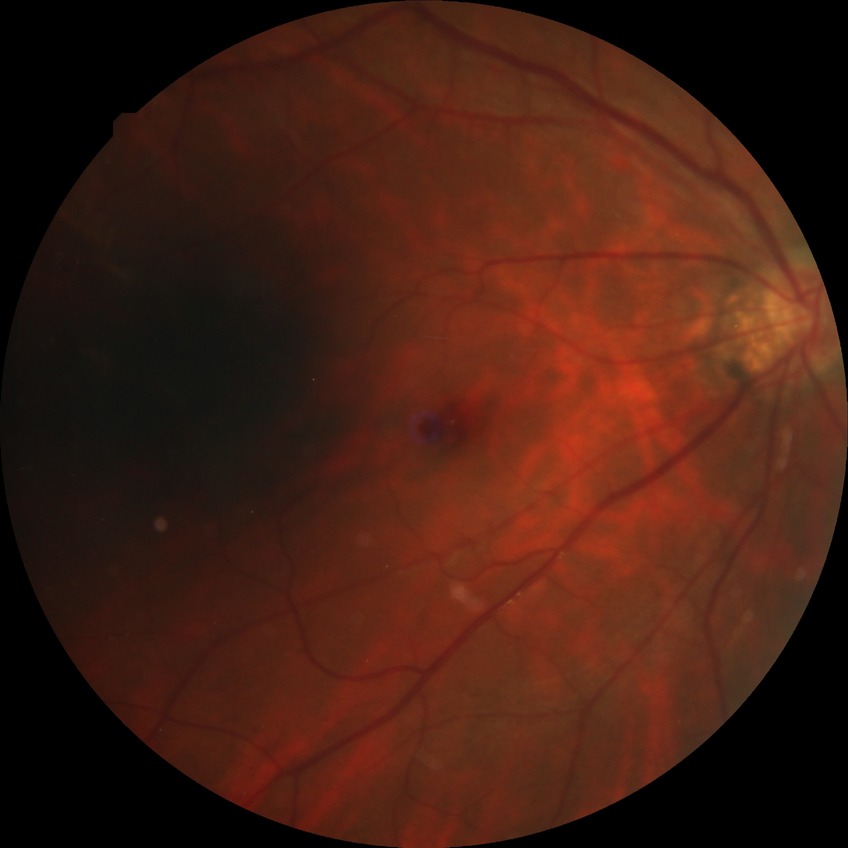 Retinopathy stage is no diabetic retinopathy.